848 by 848 pixels:
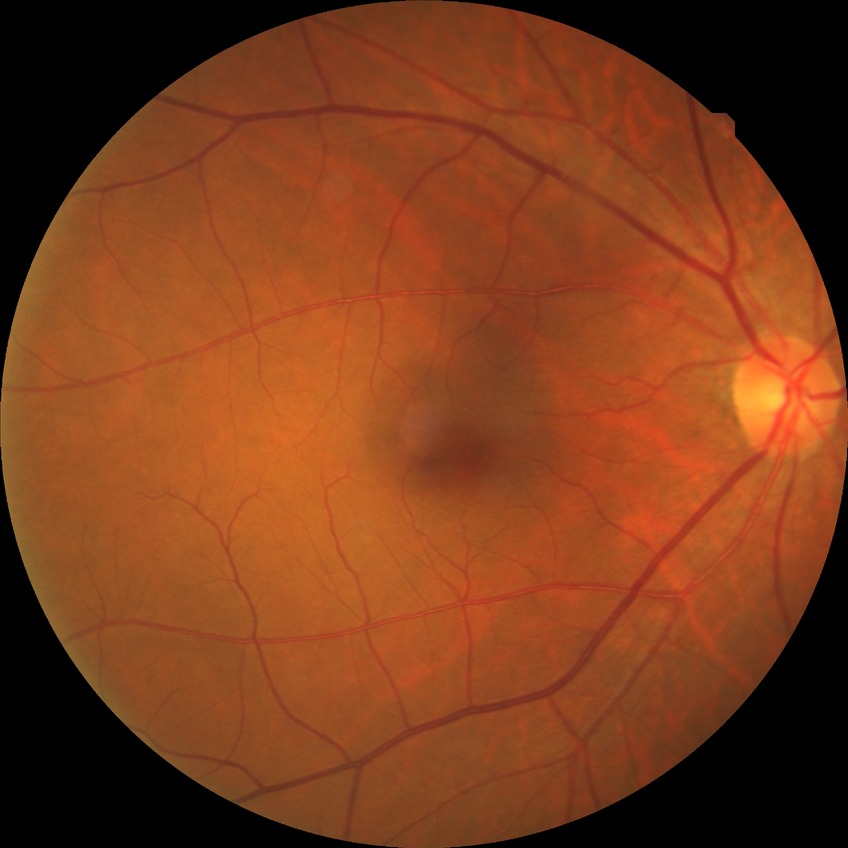 DR severity is NDR.
No DR findings.